Posterior pole color fundus photograph:
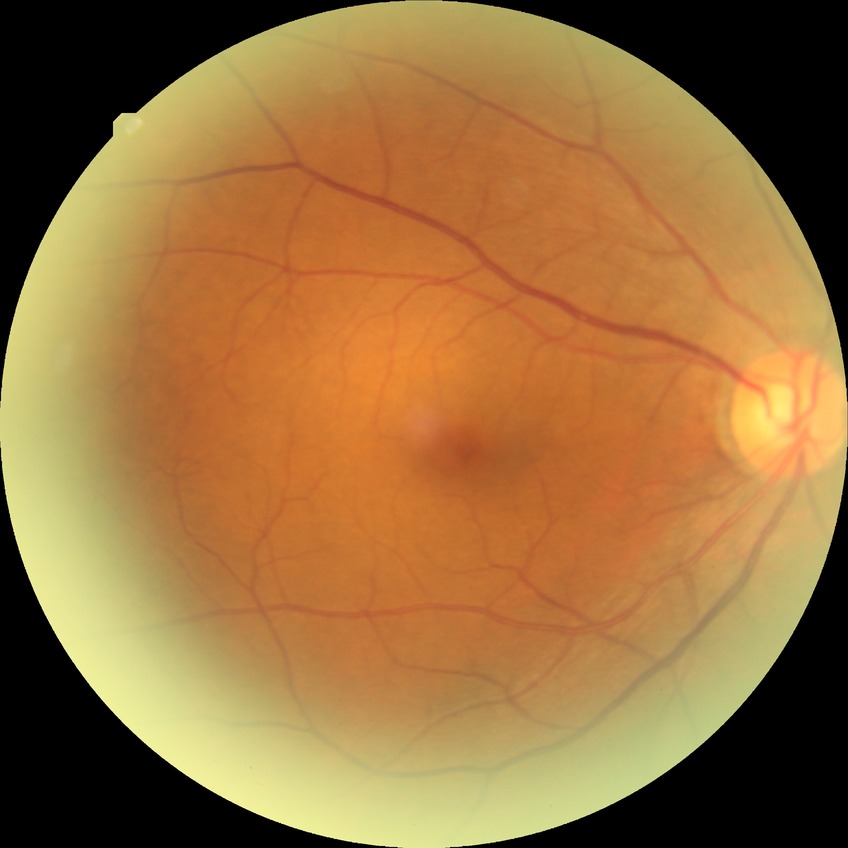 The retinopathy is classified as non-proliferative diabetic retinopathy.
Diabetic retinopathy grade is simple diabetic retinopathy.